Modified Davis grading · color fundus photograph:
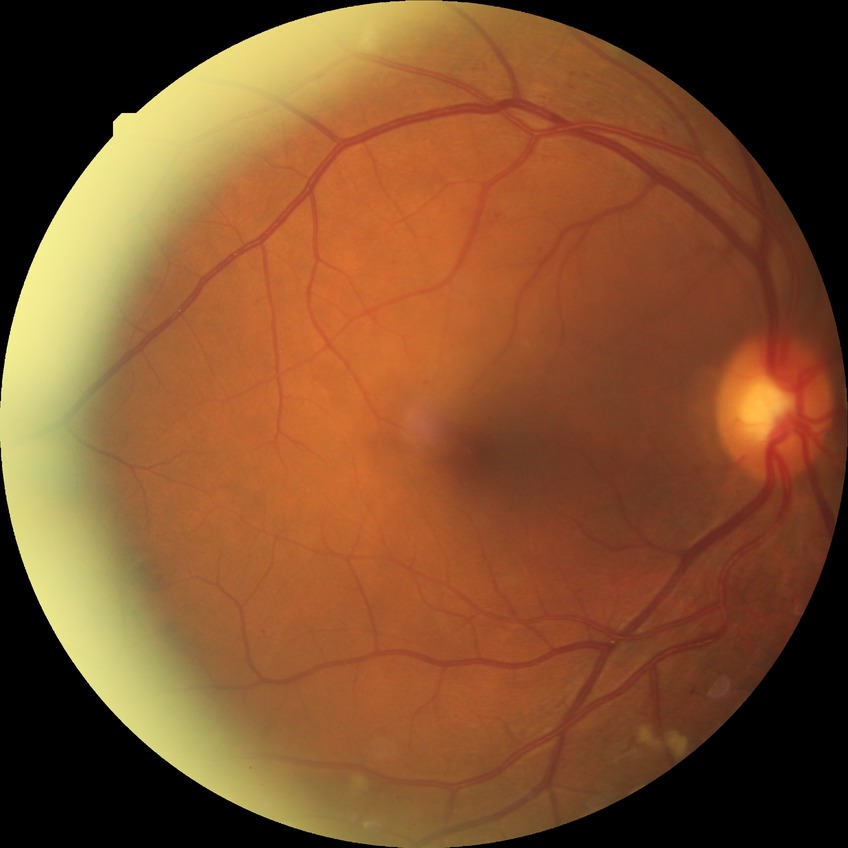 Modified Davis grading is pre-proliferative diabetic retinopathy.